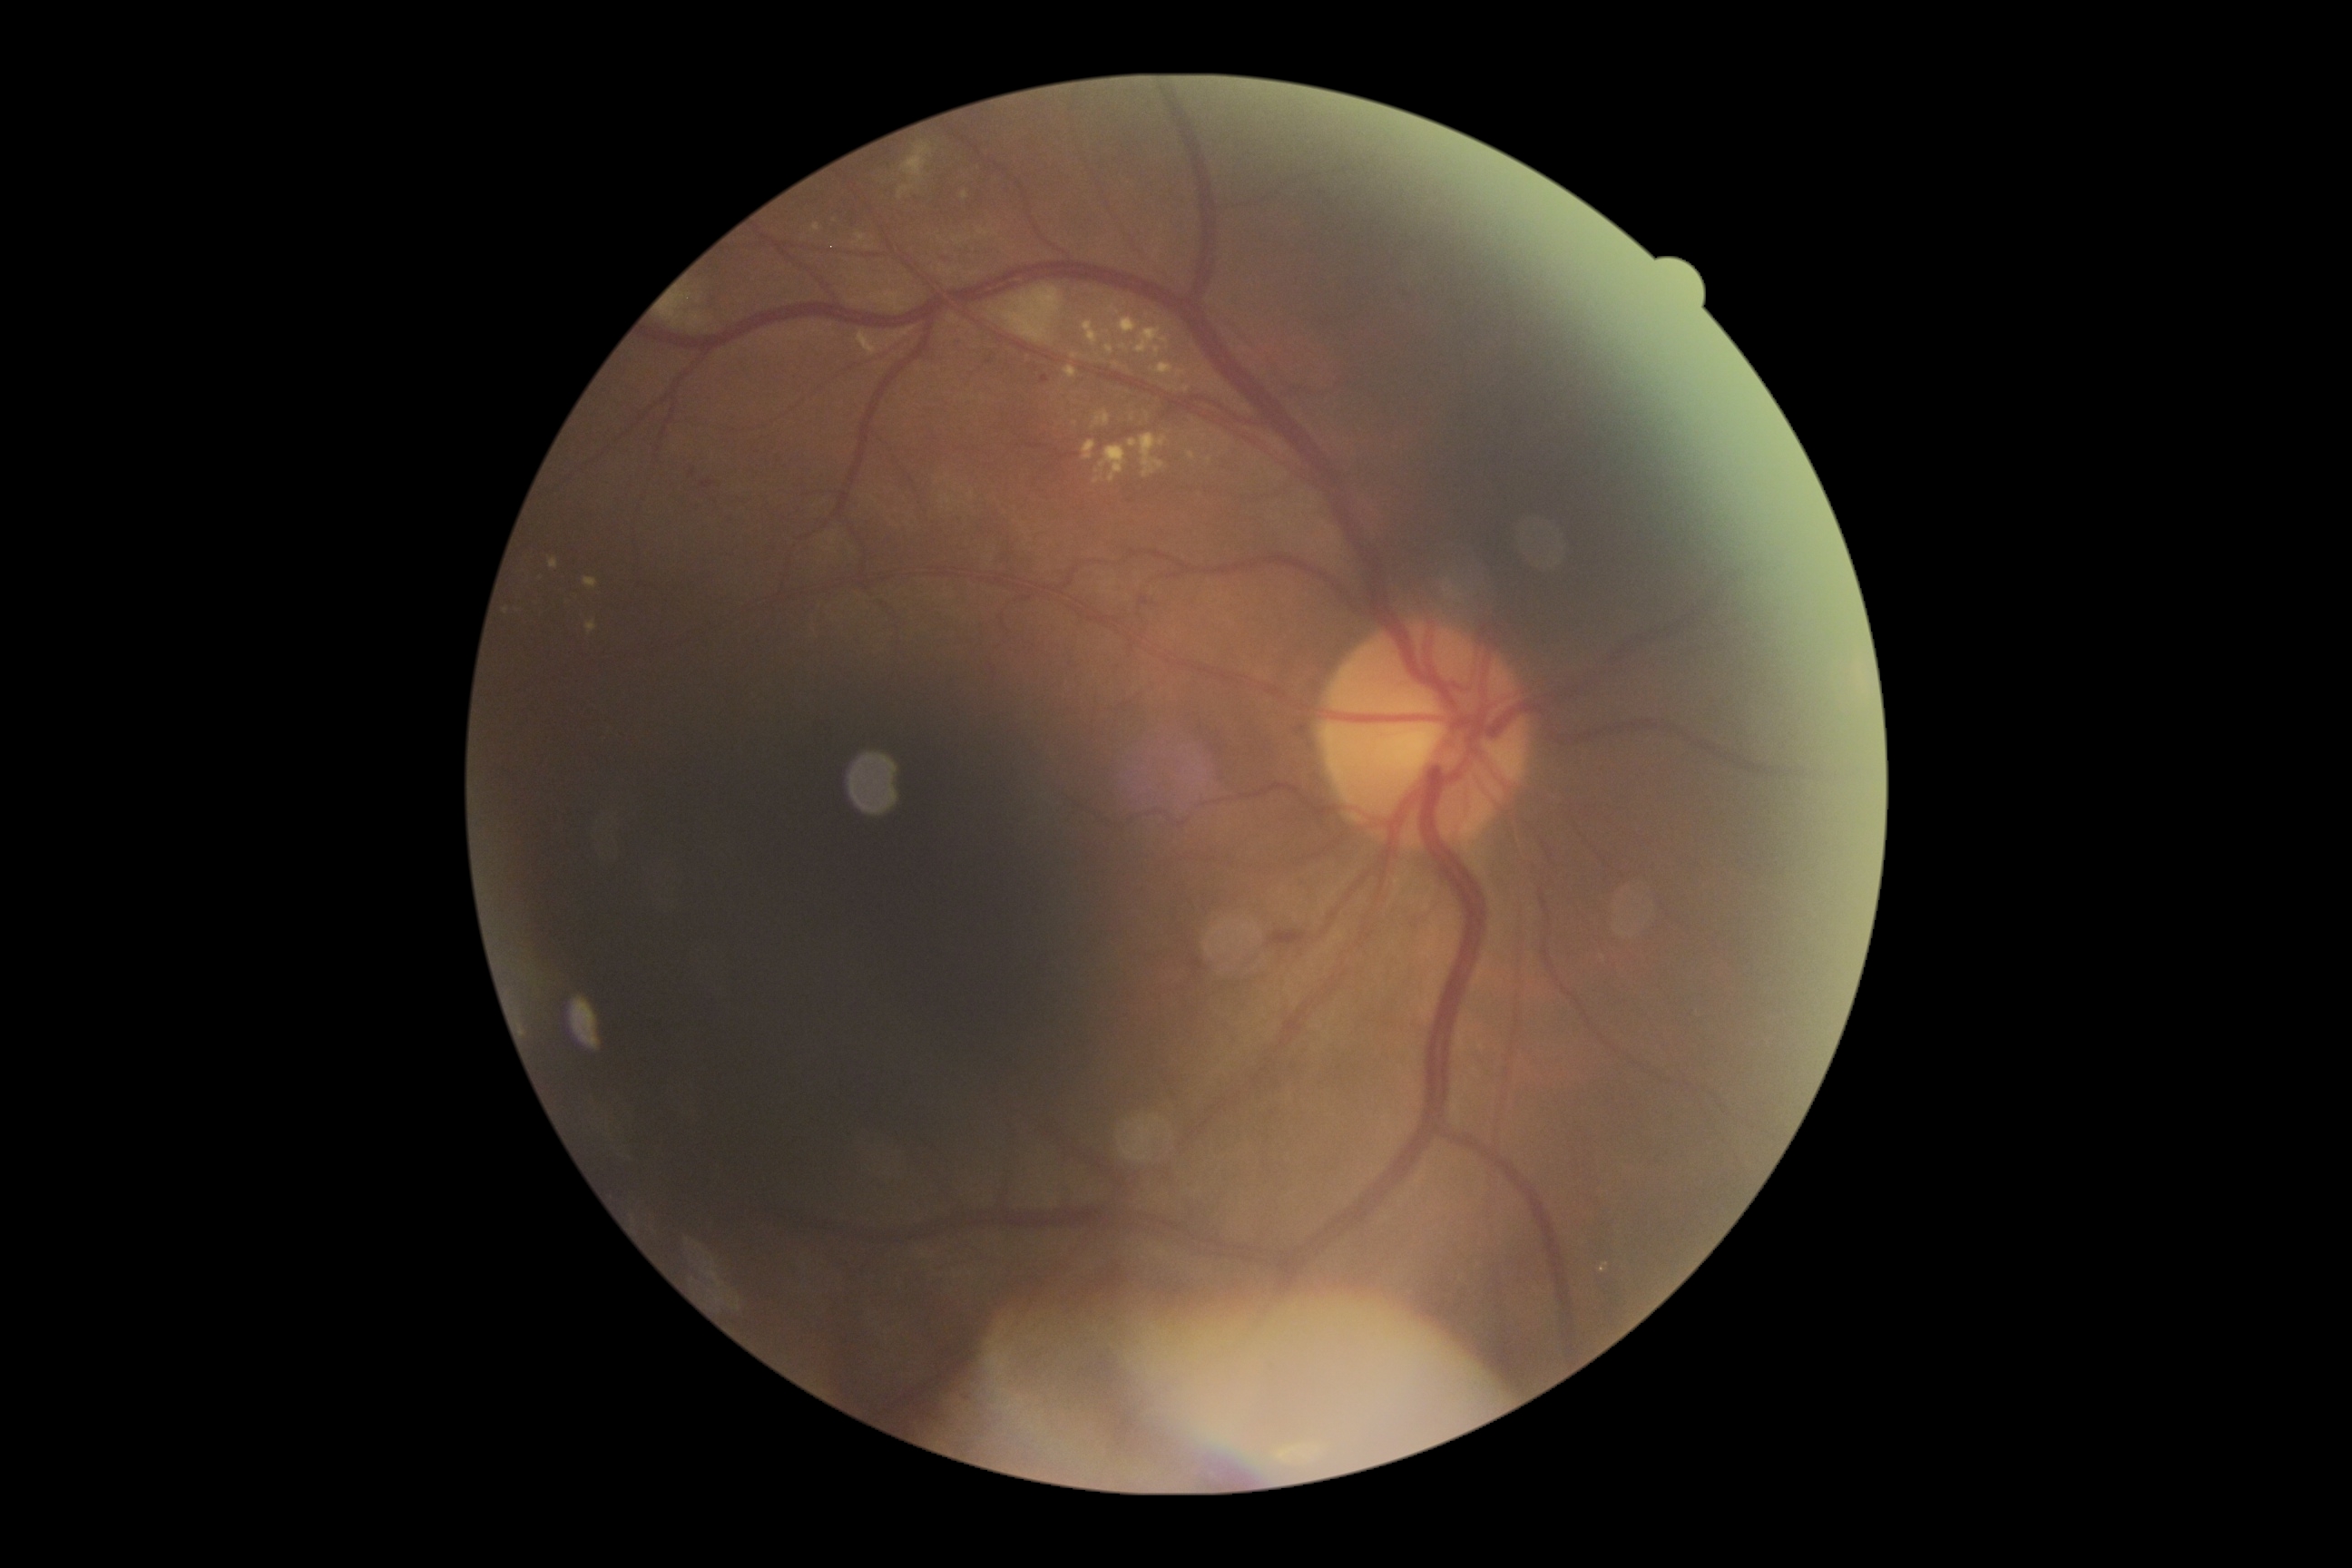 diabetic retinopathy = moderate non-proliferative diabetic retinopathy (grade 2).